RetCam wide-field infant fundus image · Natus RetCam Envision, 130° FOV:
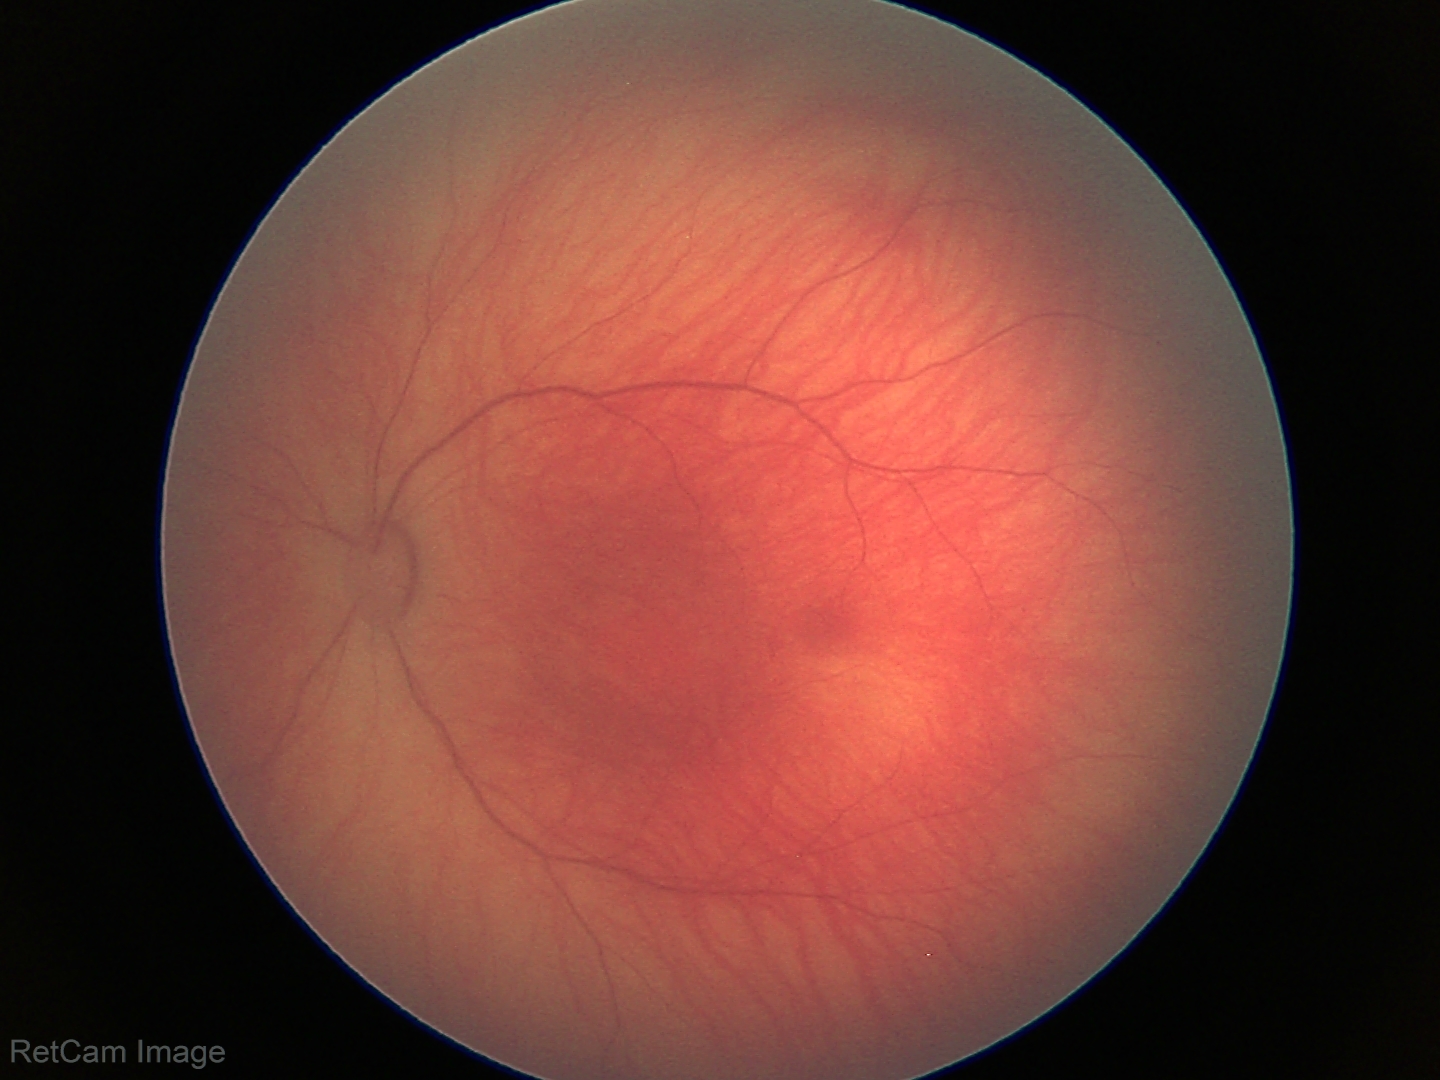

Examination with physiological retinal findings.